2352x1568px, 45° FOV:
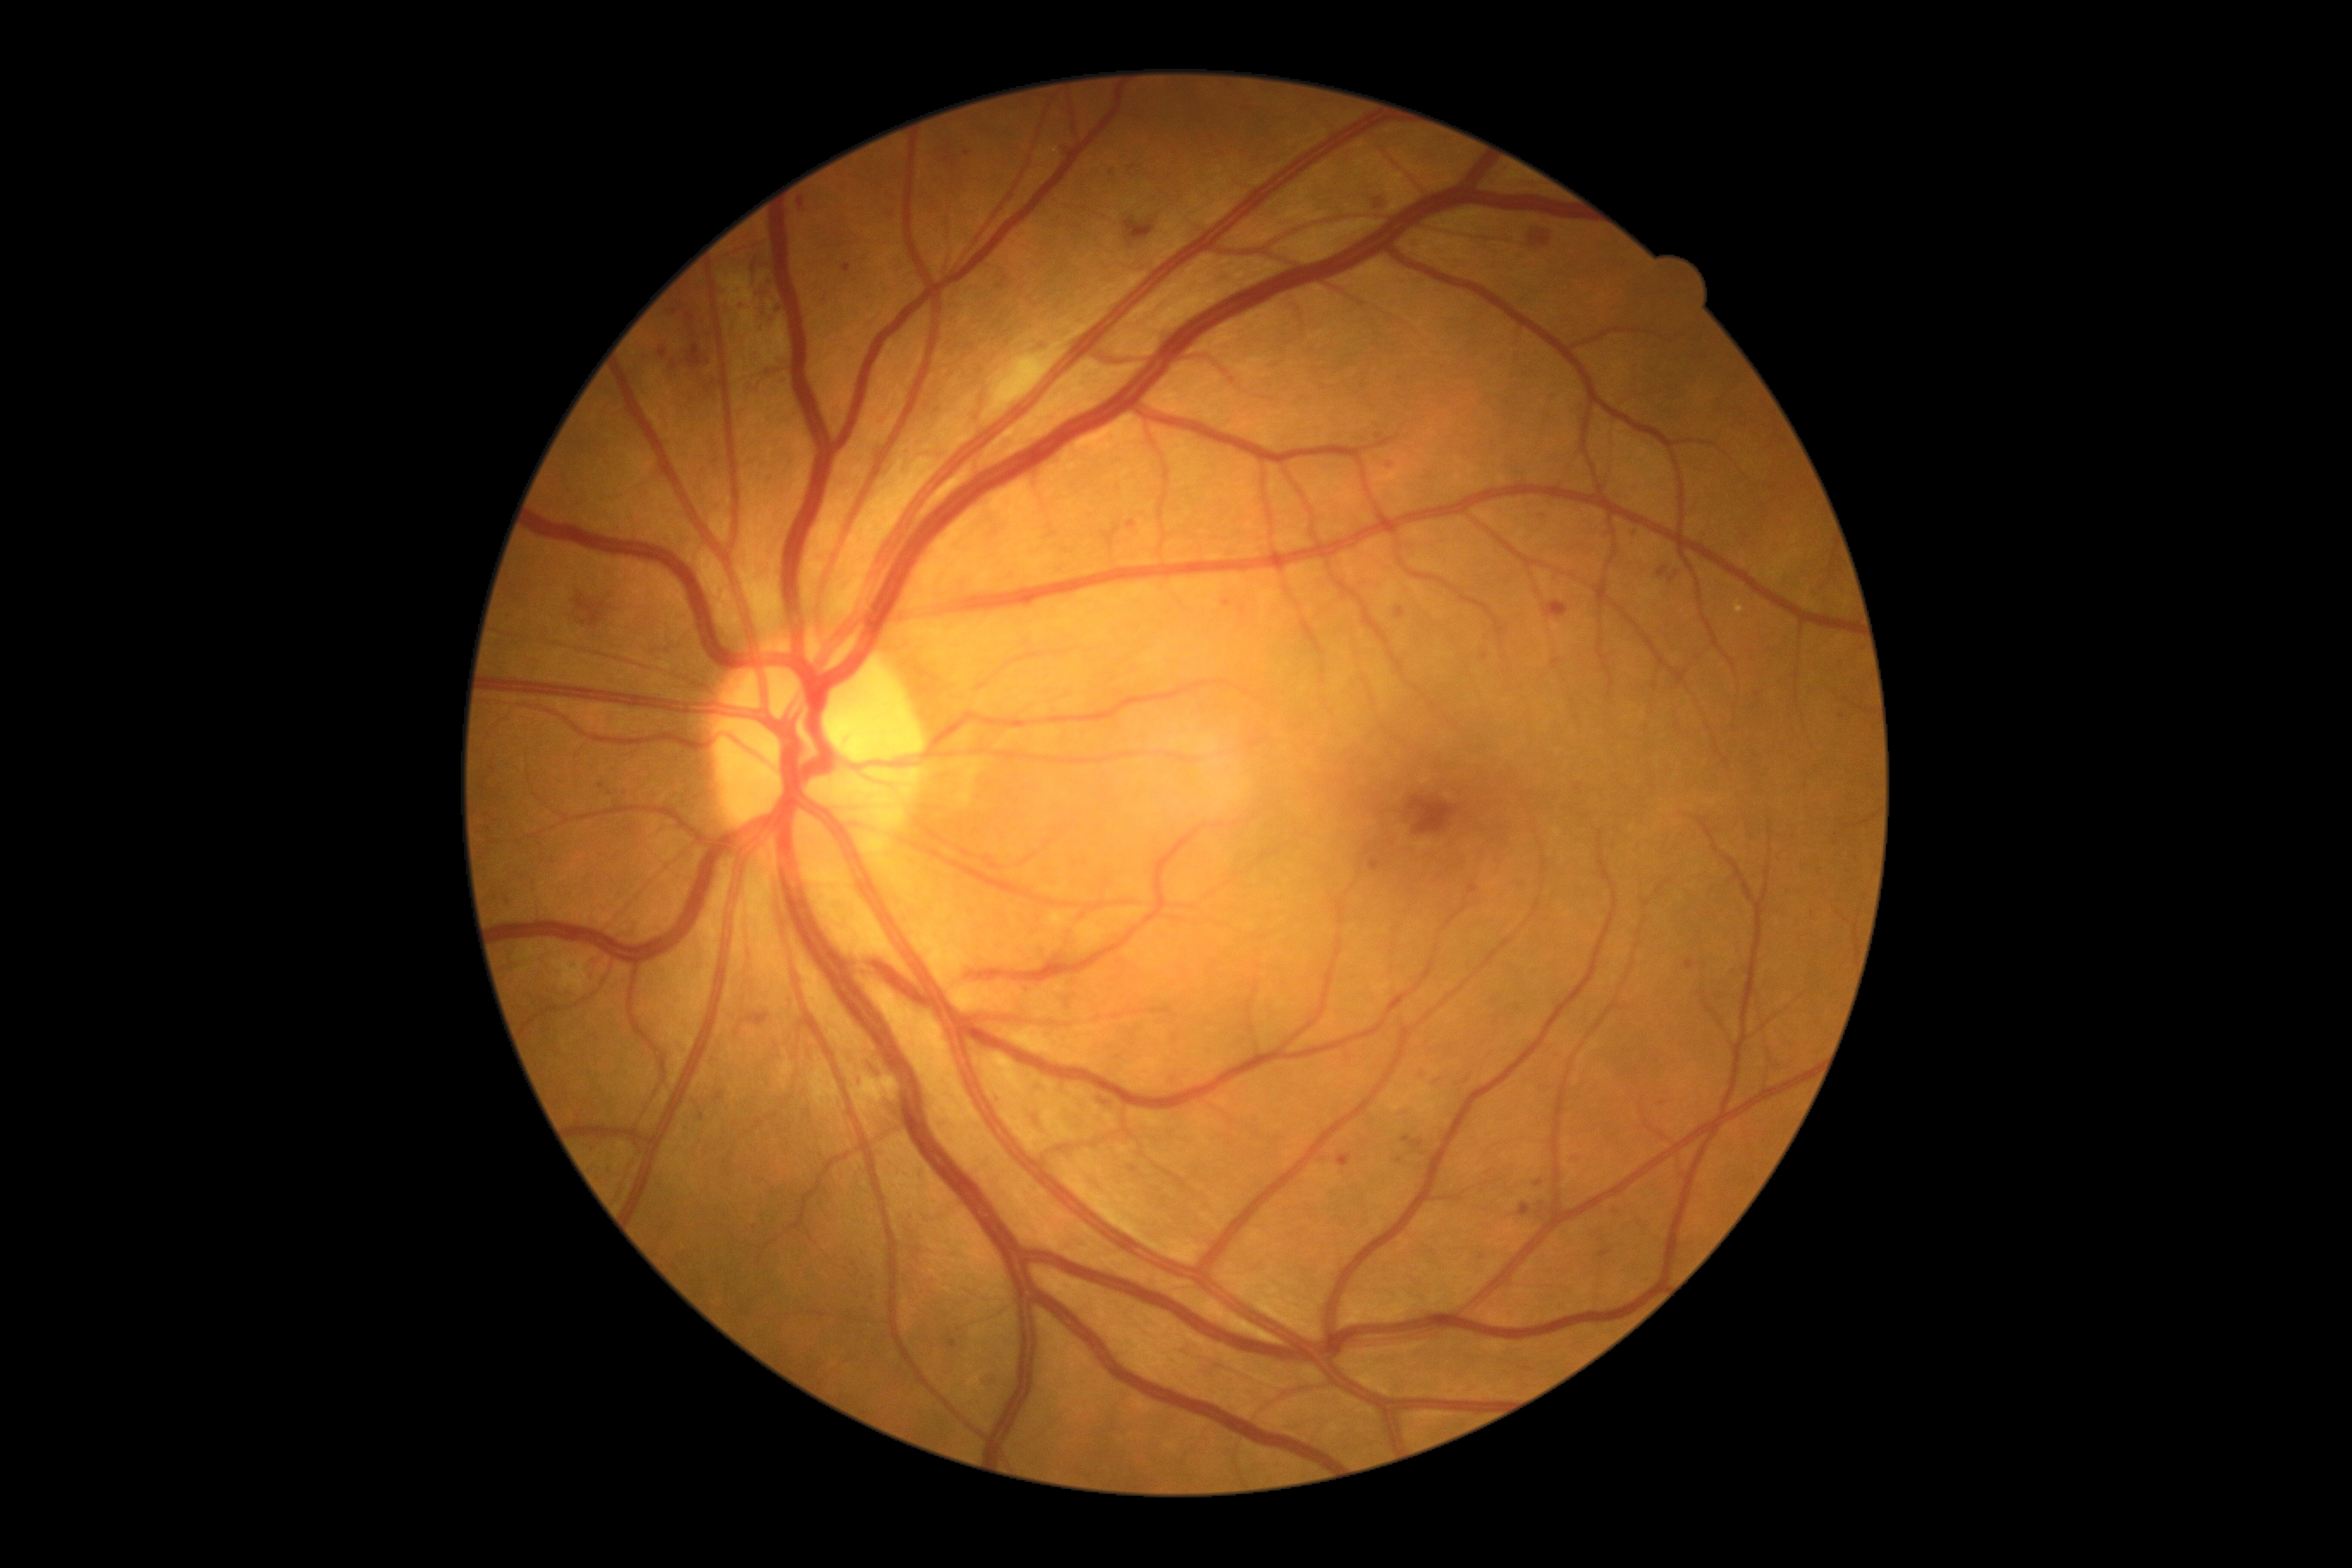 DR is moderate non-proliferative diabetic retinopathy (grade 2) — more than just microaneurysms but less than severe NPDR.